2352x1568, 45° field of view
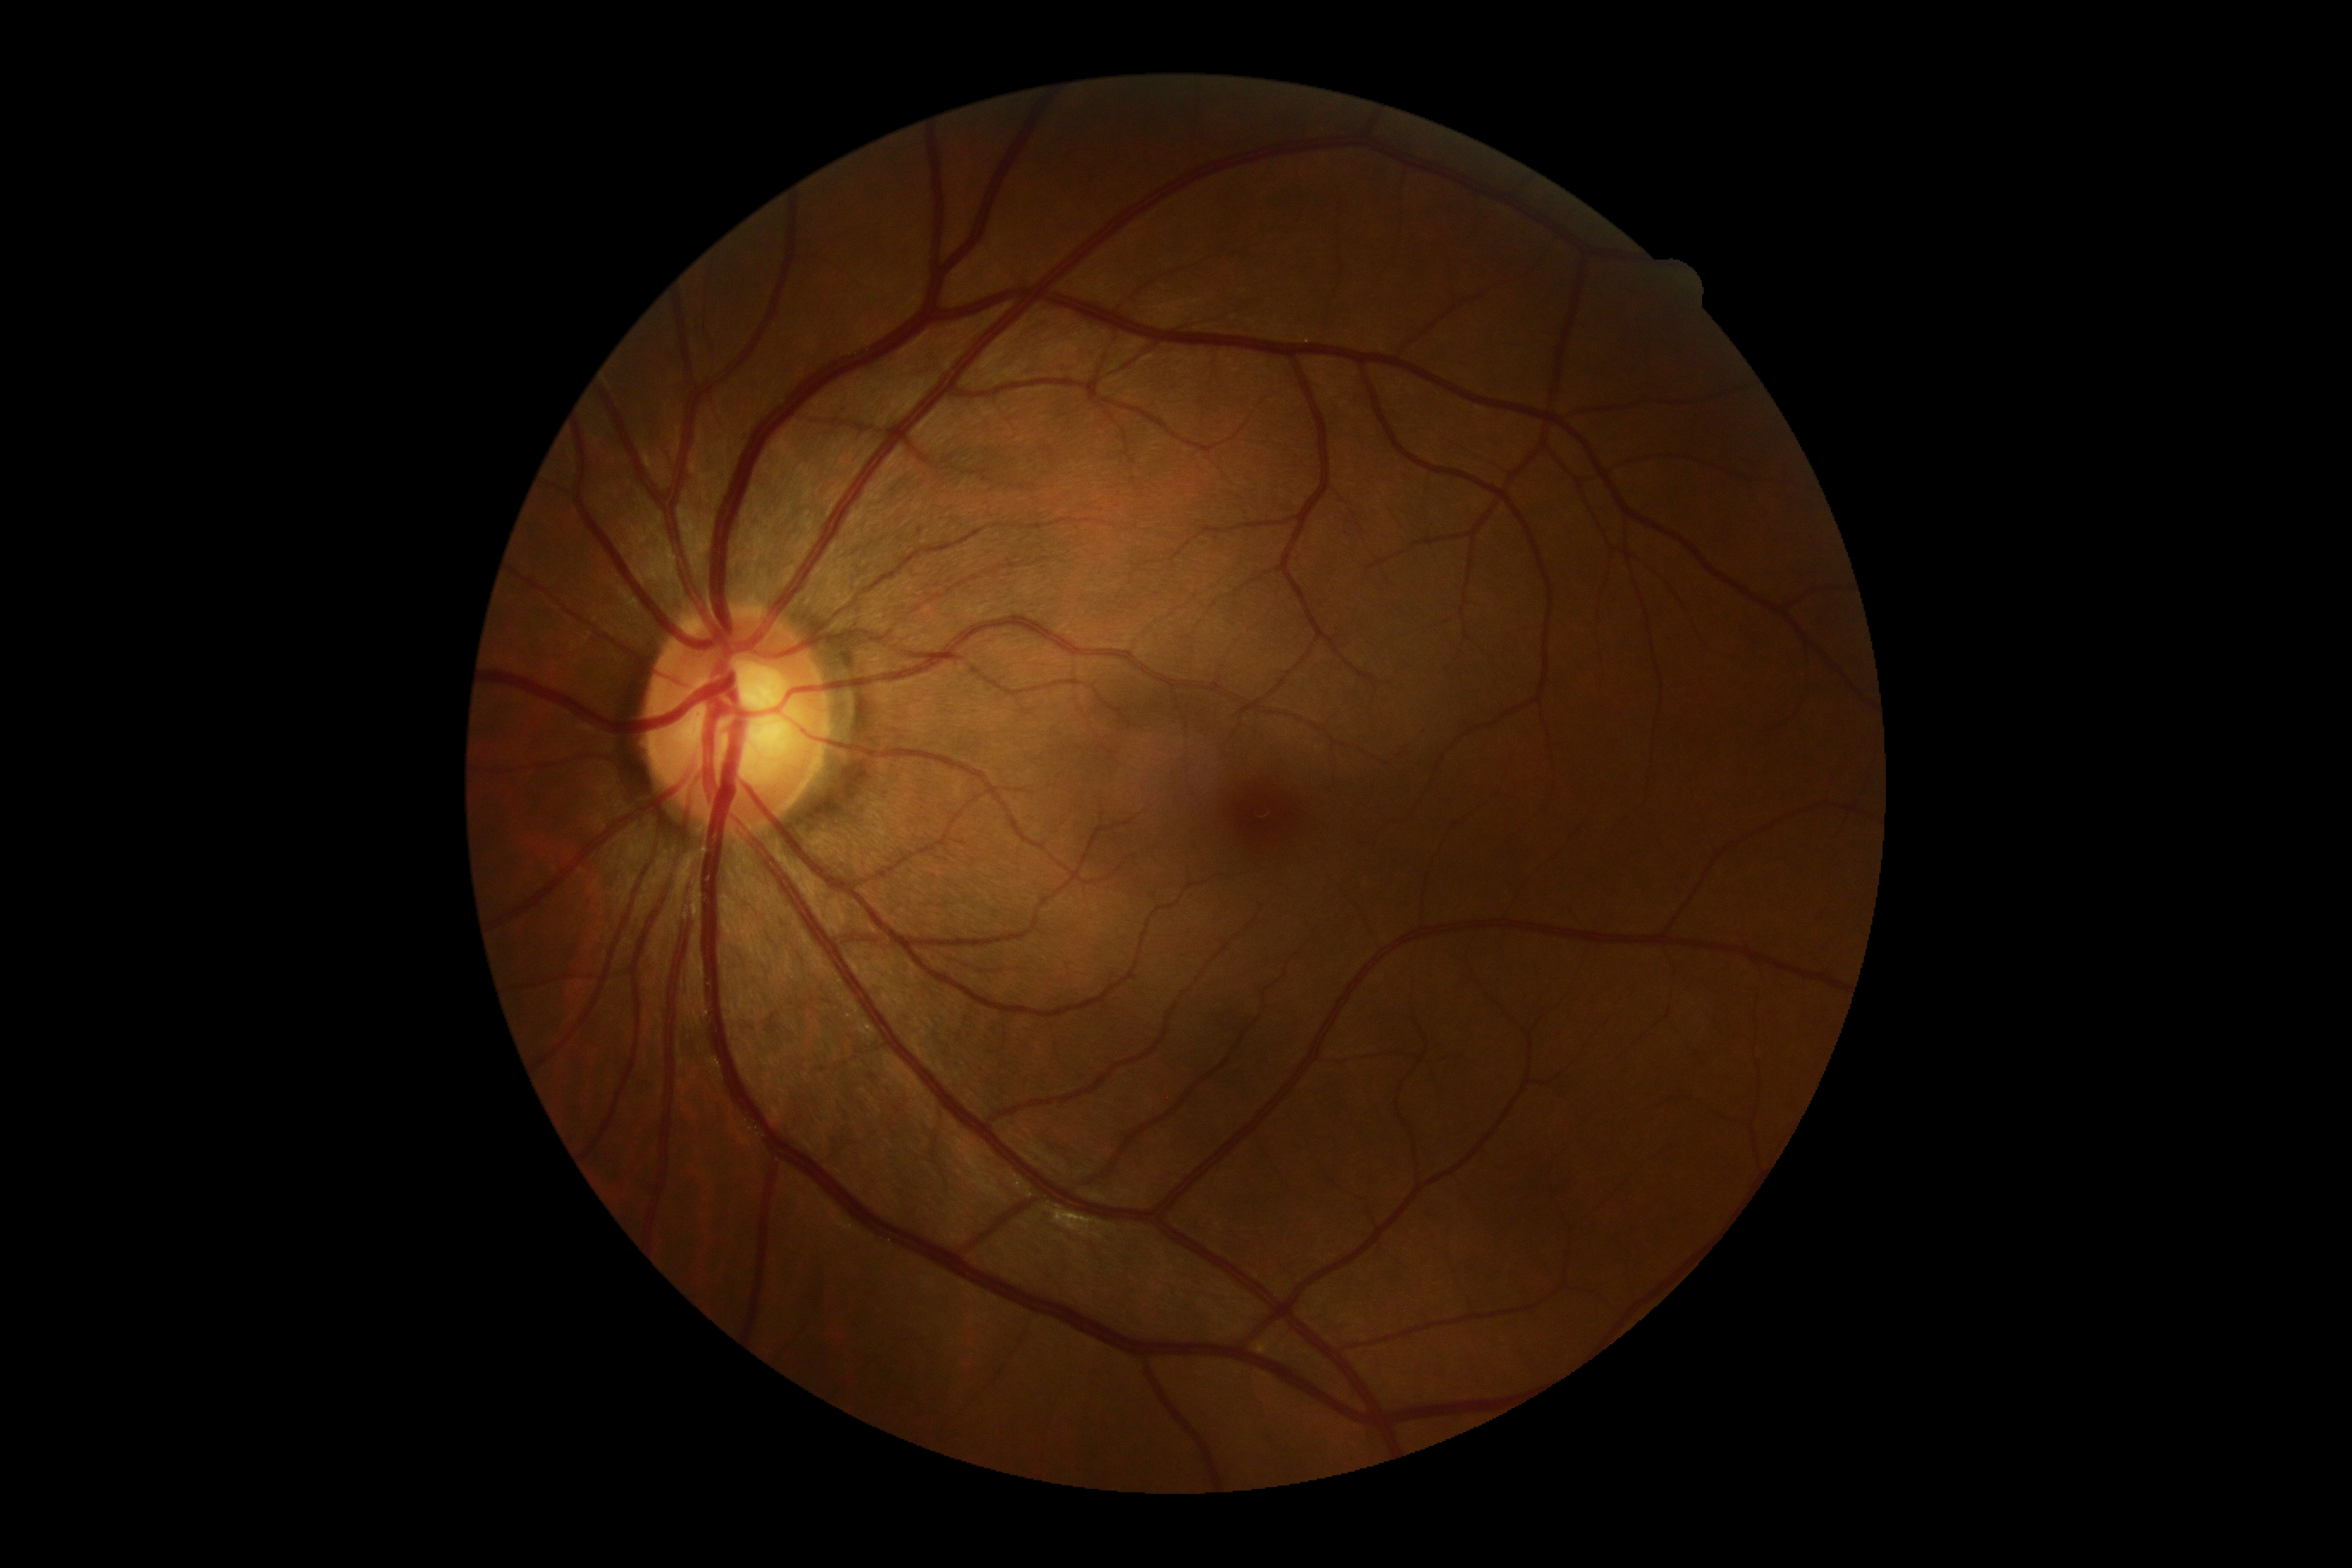 DR severity is 0.